45° field of view · color fundus image · 1932x1916
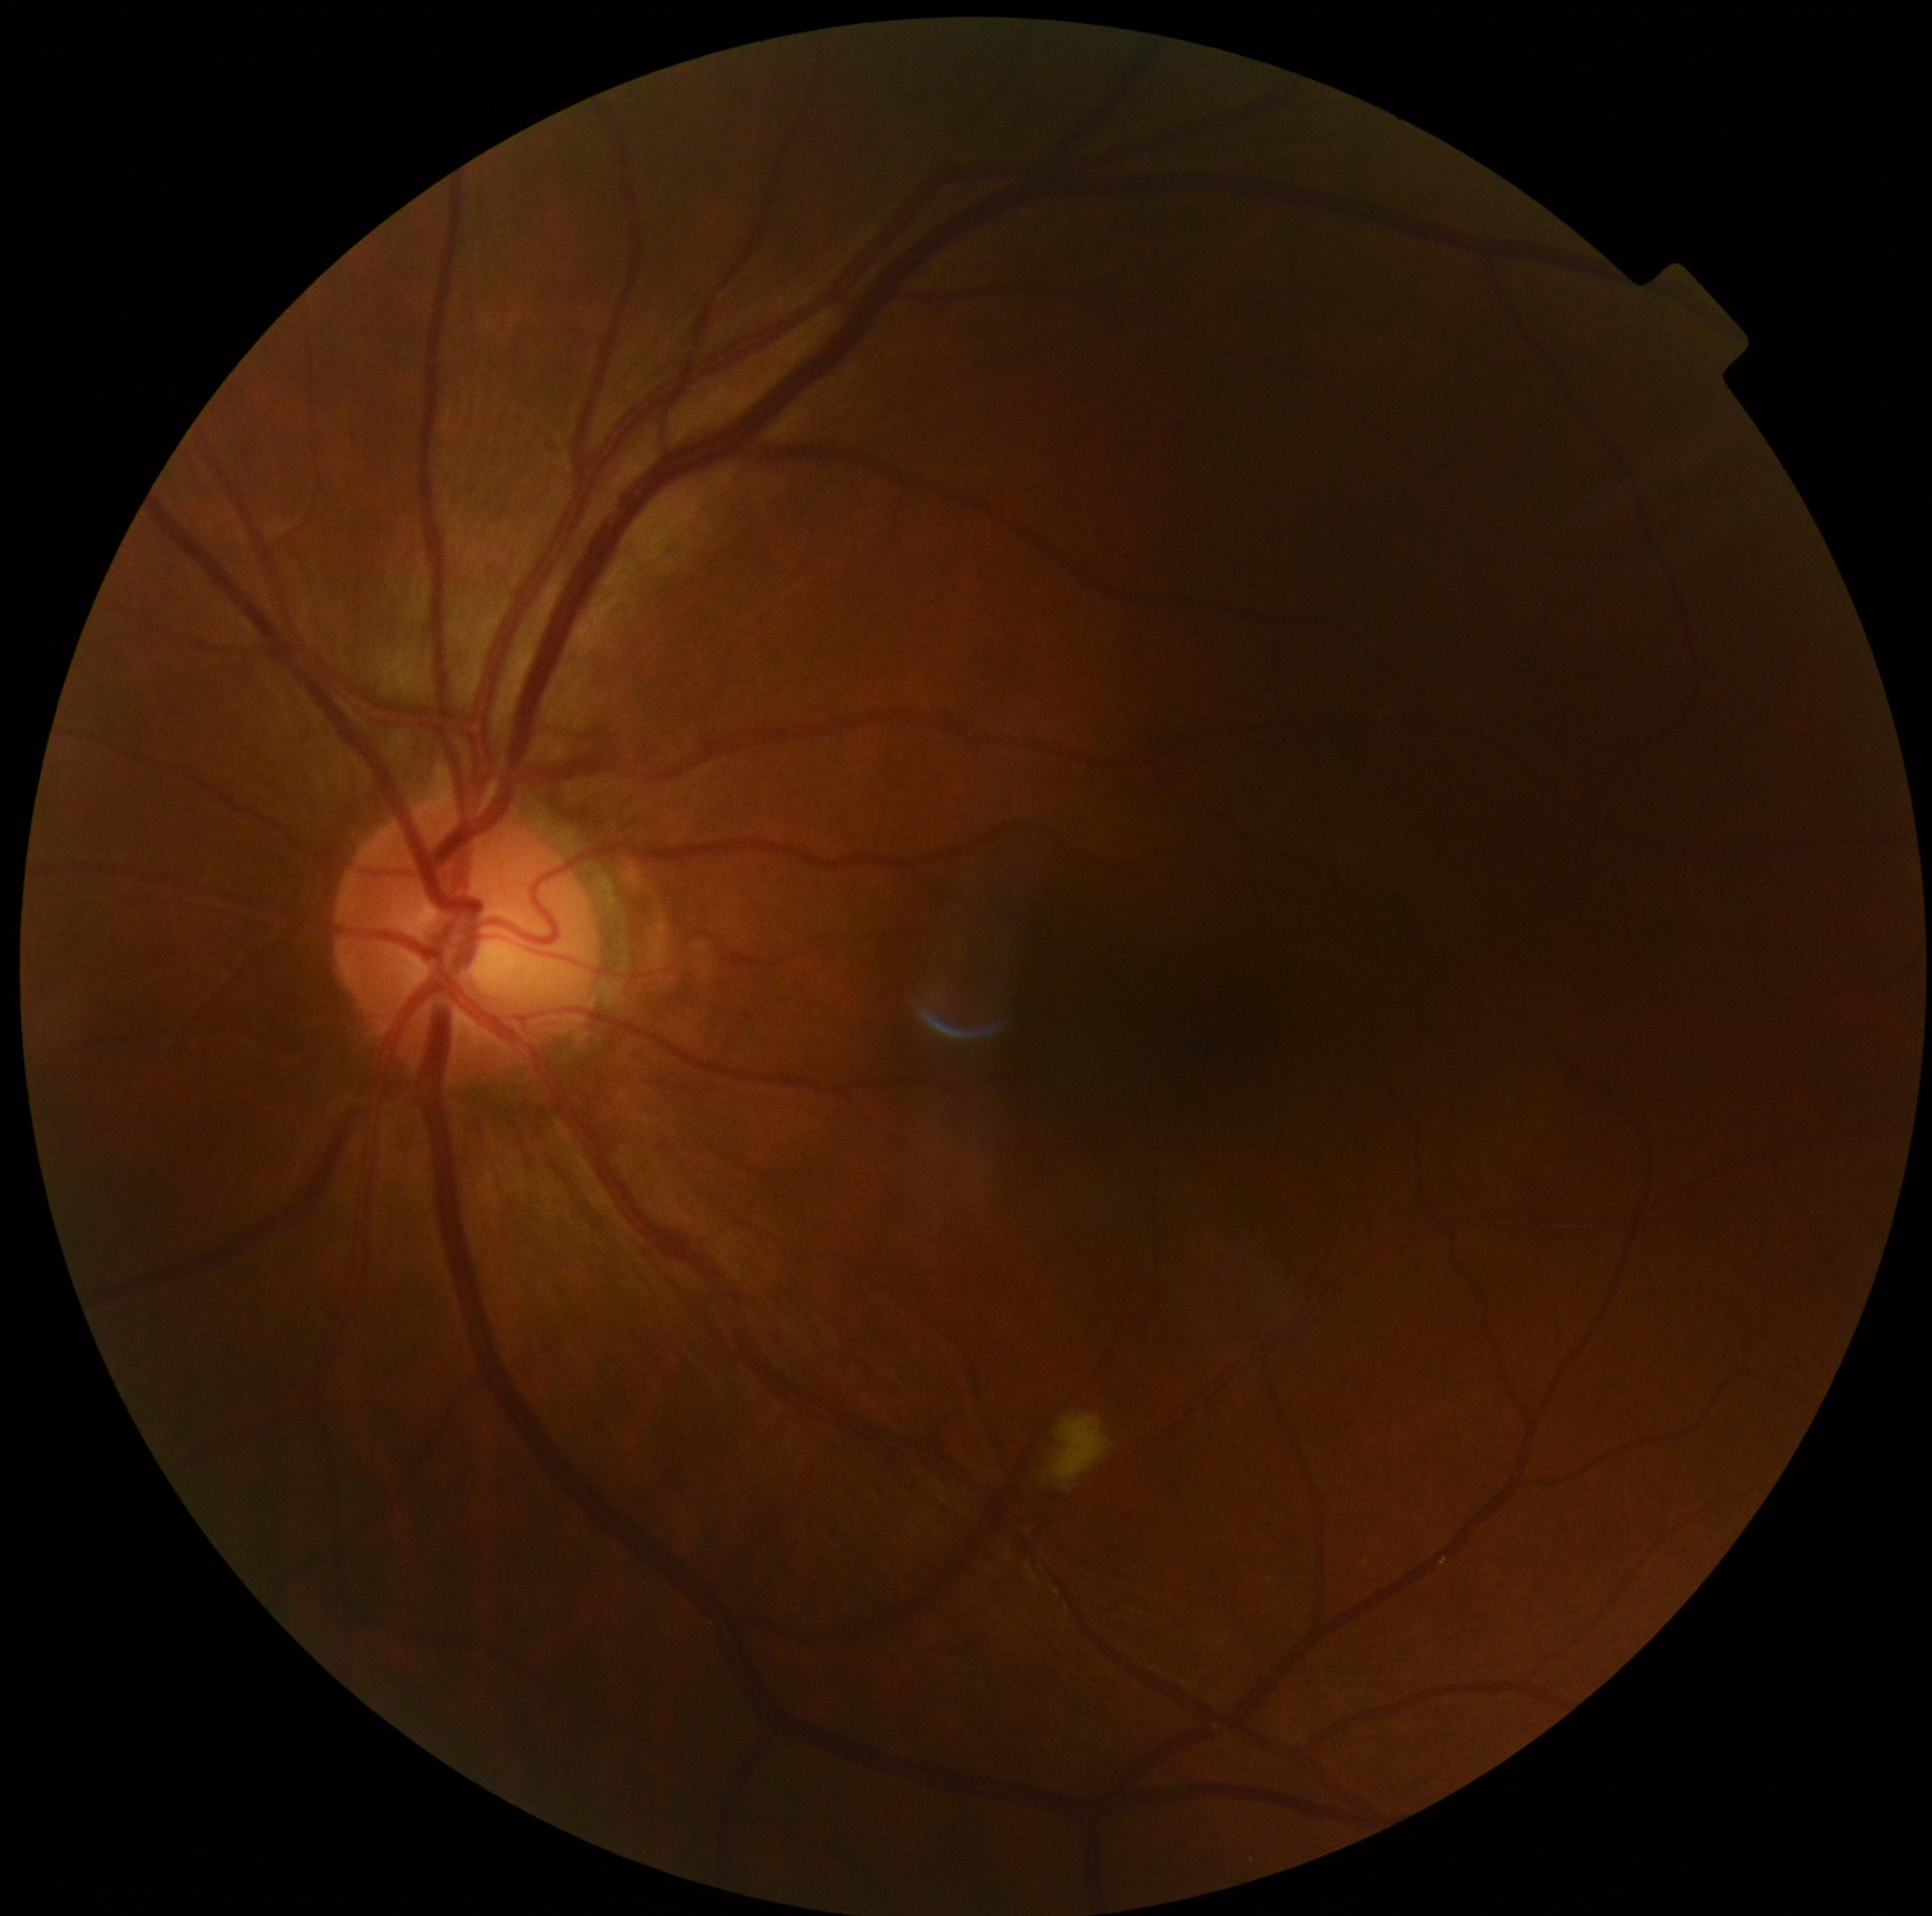 Retinopathy is grade 2 (moderate NPDR) — more than just microaneurysms but less than severe NPDR.